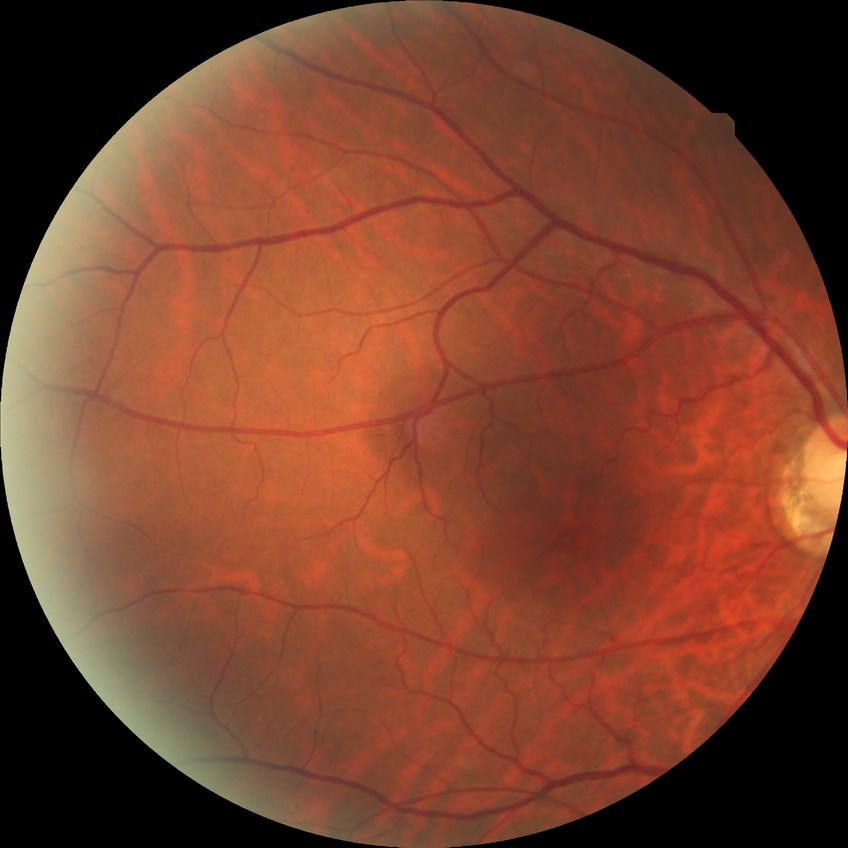
Assessment:
– DR stage — NDR